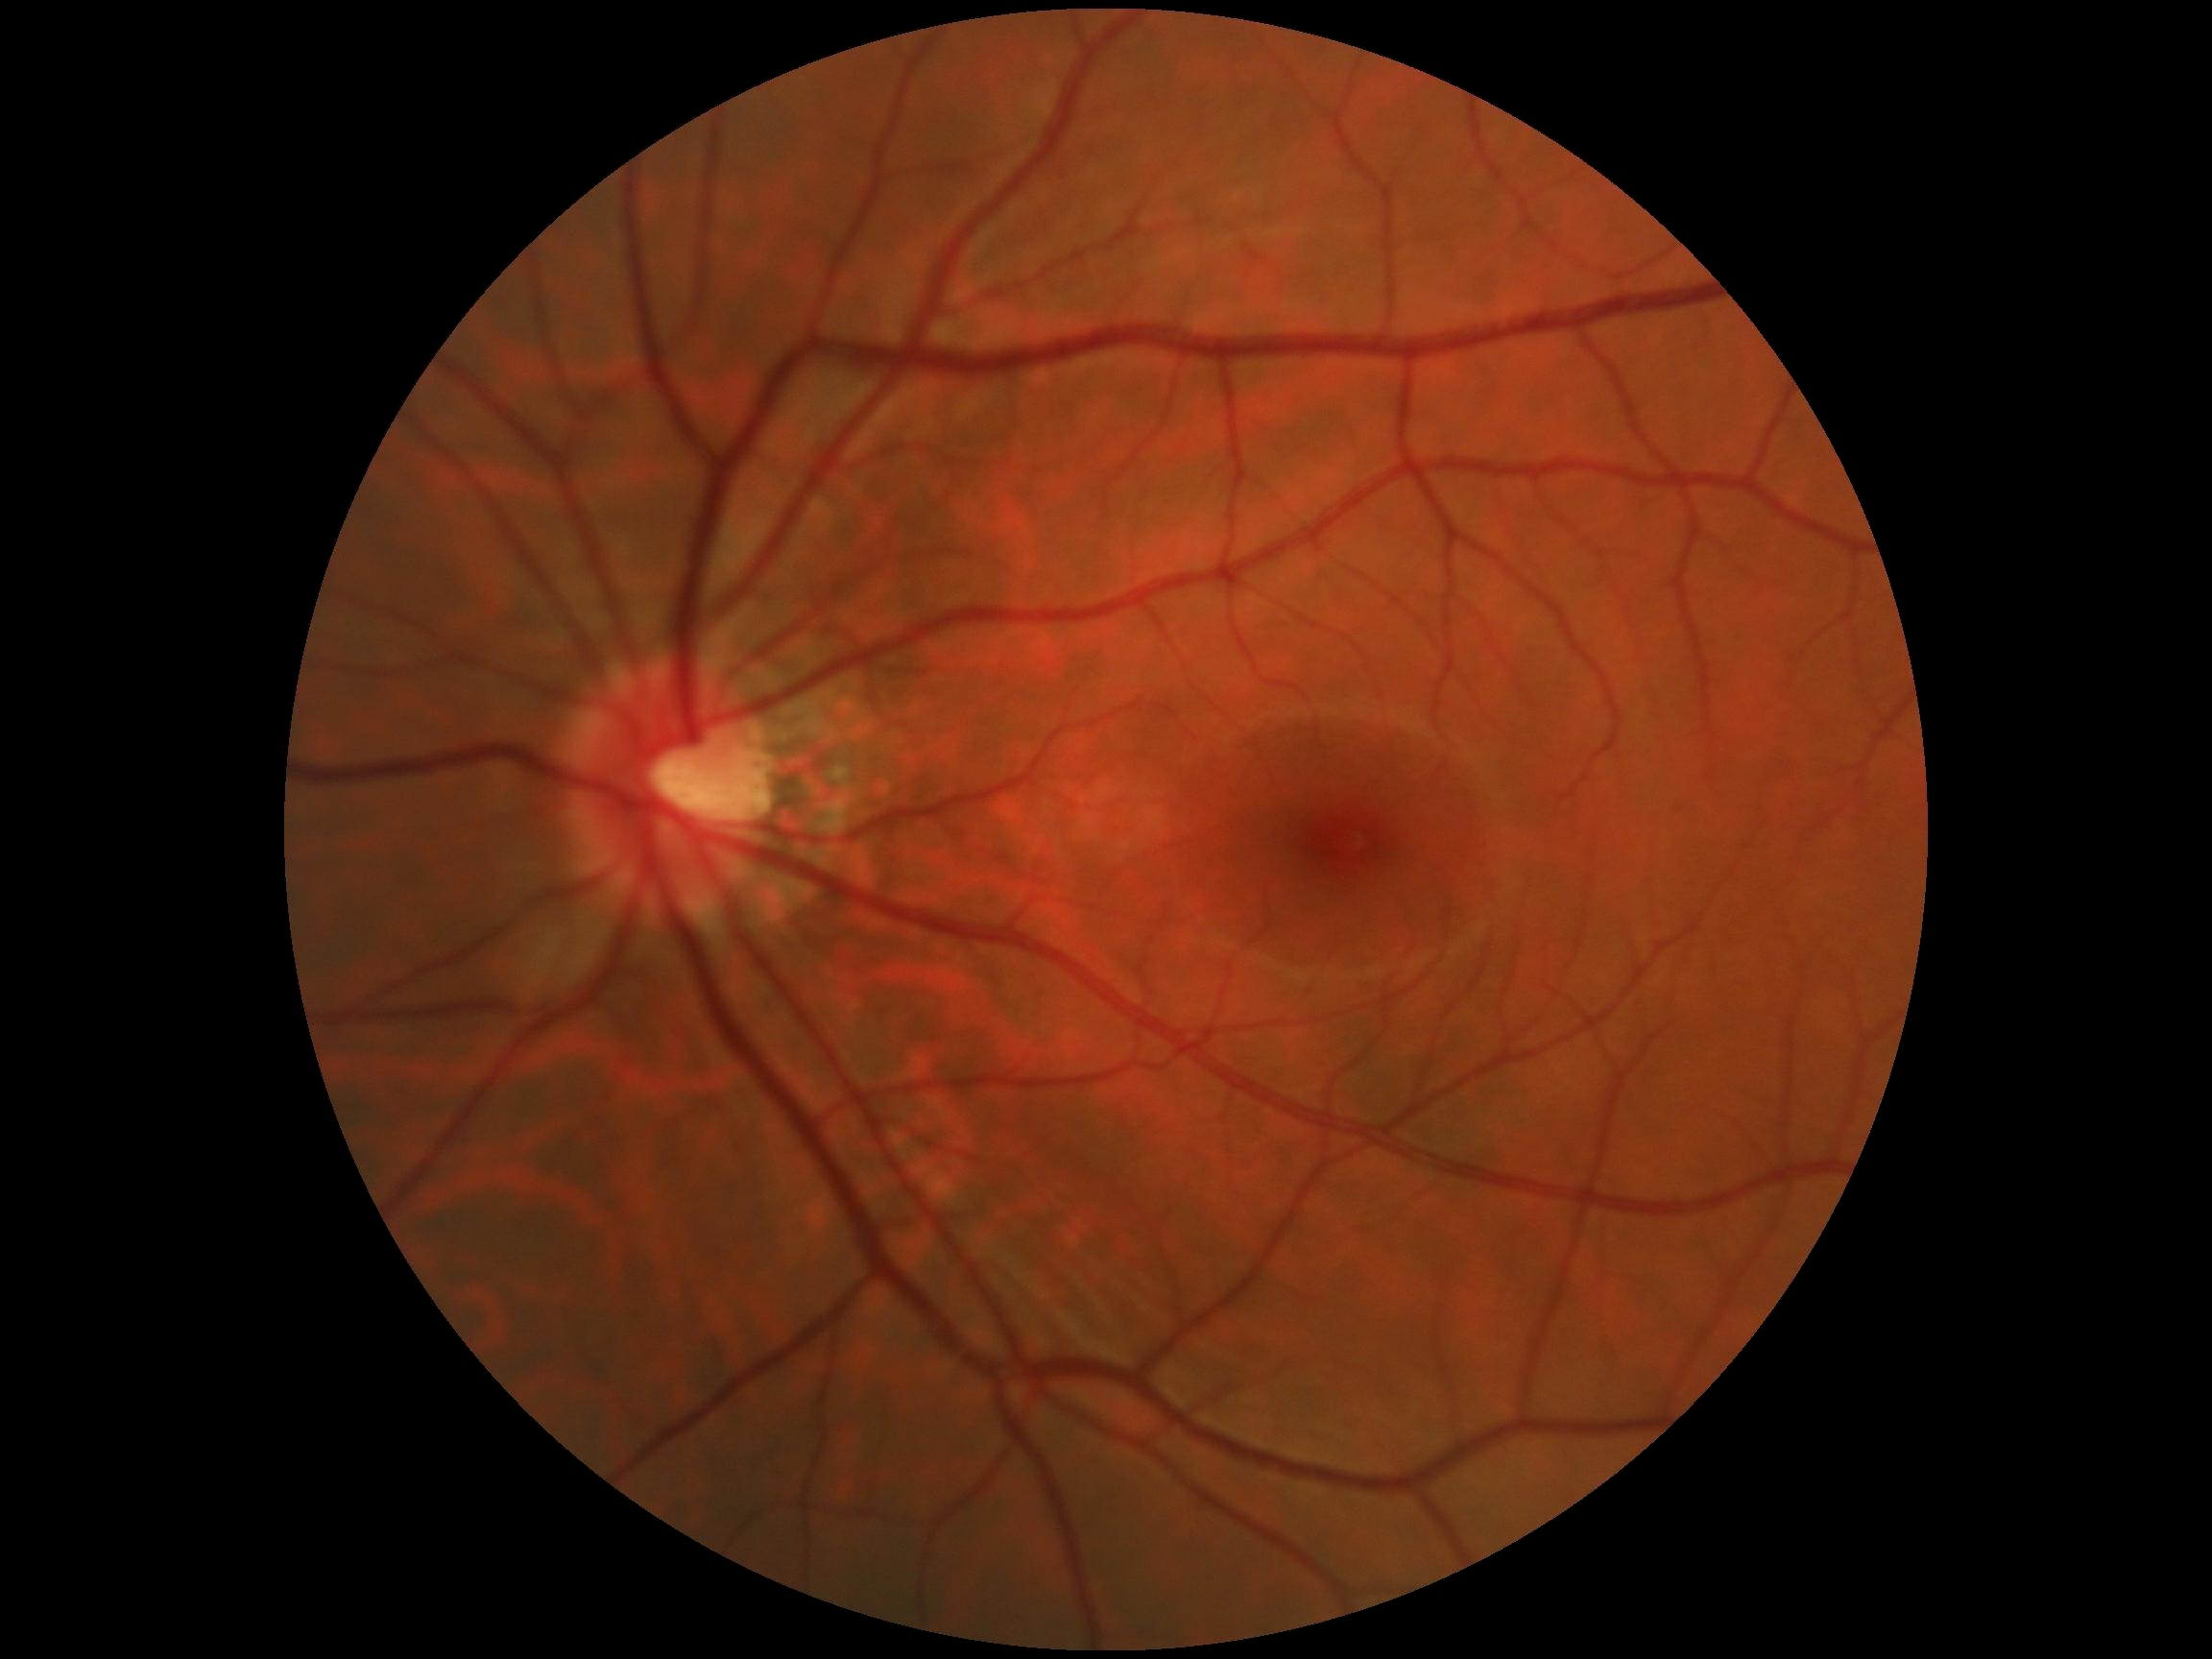

  dr_grade: grade 0 (no apparent retinopathy) — no visible signs of diabetic retinopathy